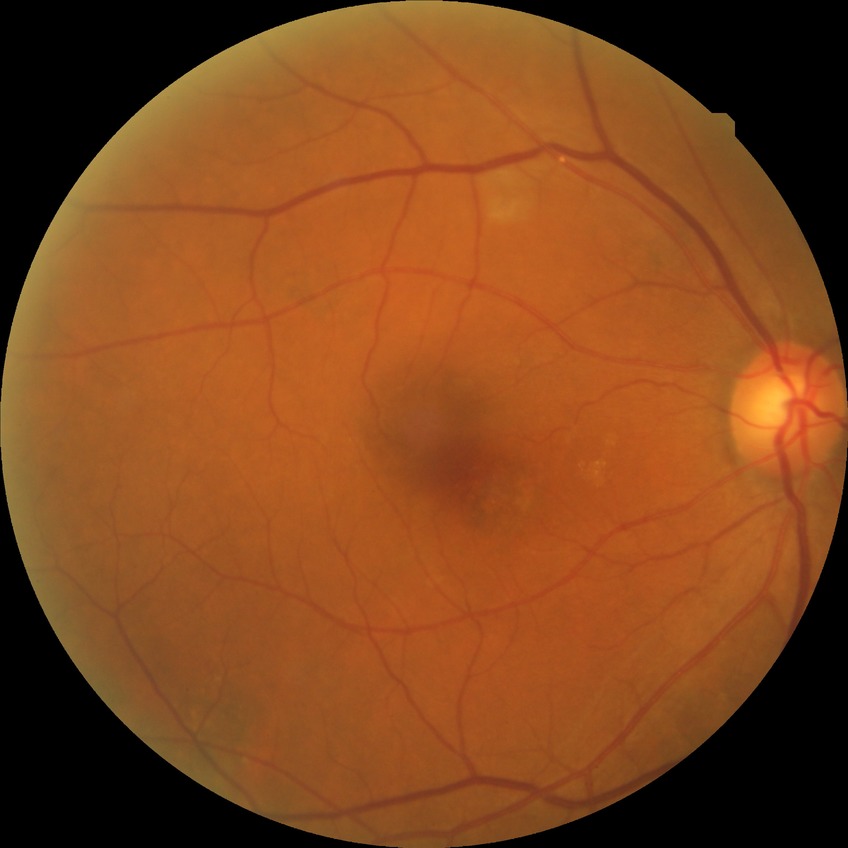

Diabetic retinopathy stage is no diabetic retinopathy.